No pharmacologic dilation. 45-degree field of view. NIDEK AFC-230. 848 by 848 pixels.
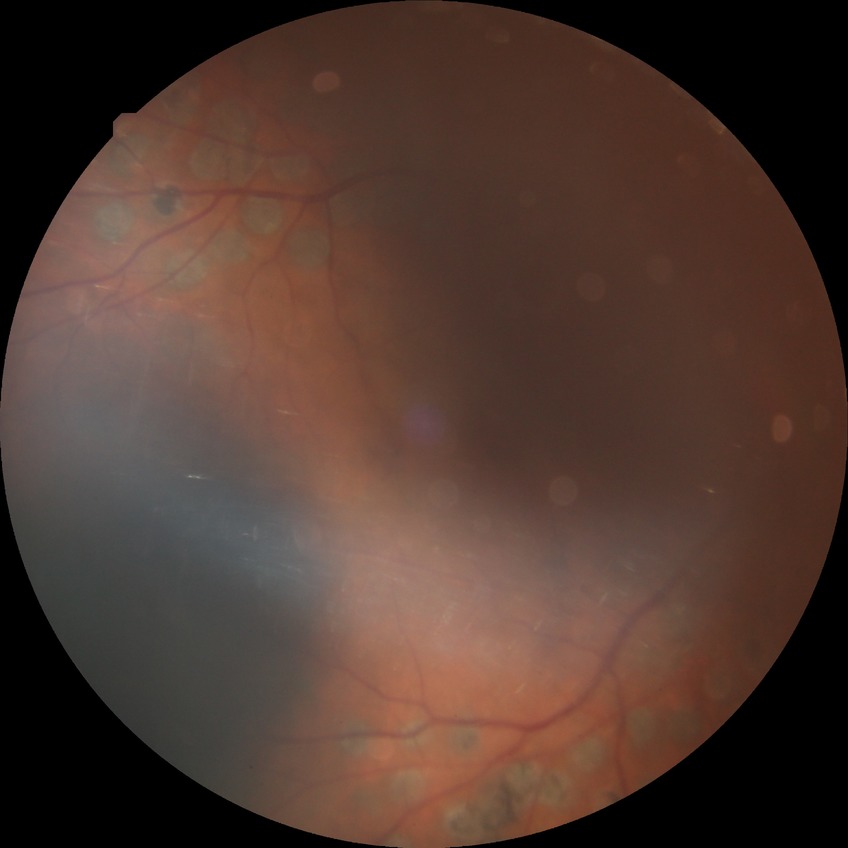
Retinopathy grade is proliferative diabetic retinopathy.